Color fundus image
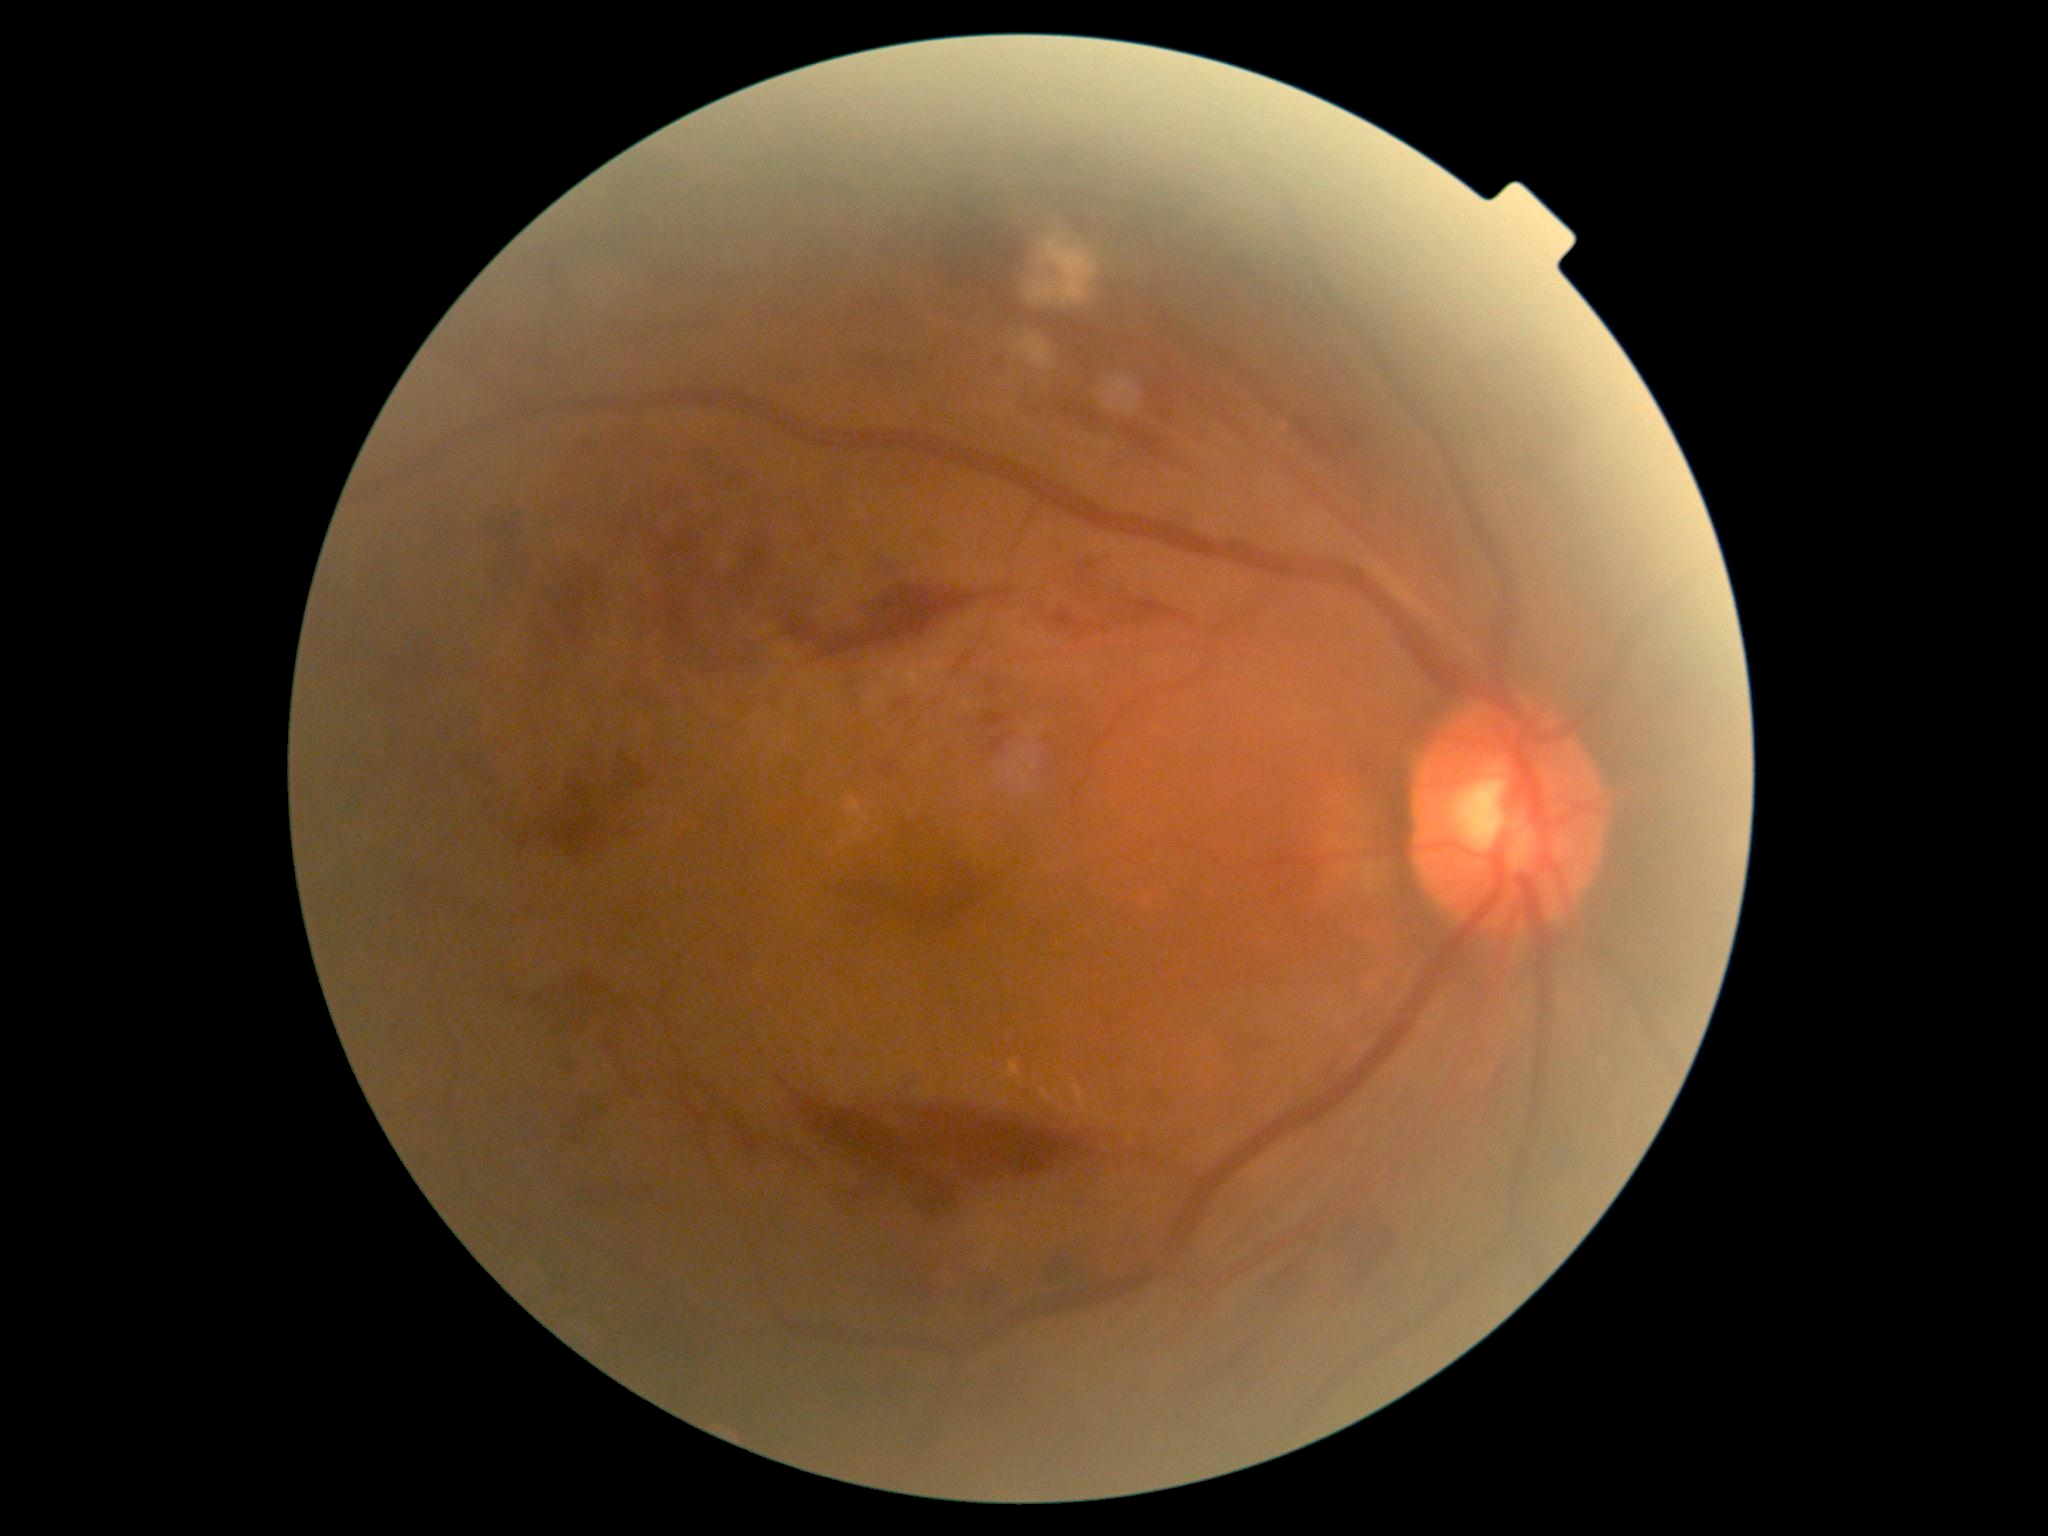
Diabetic retinopathy (DR): grade 3 (severe NPDR).